2212 by 1672 pixels; CFP: 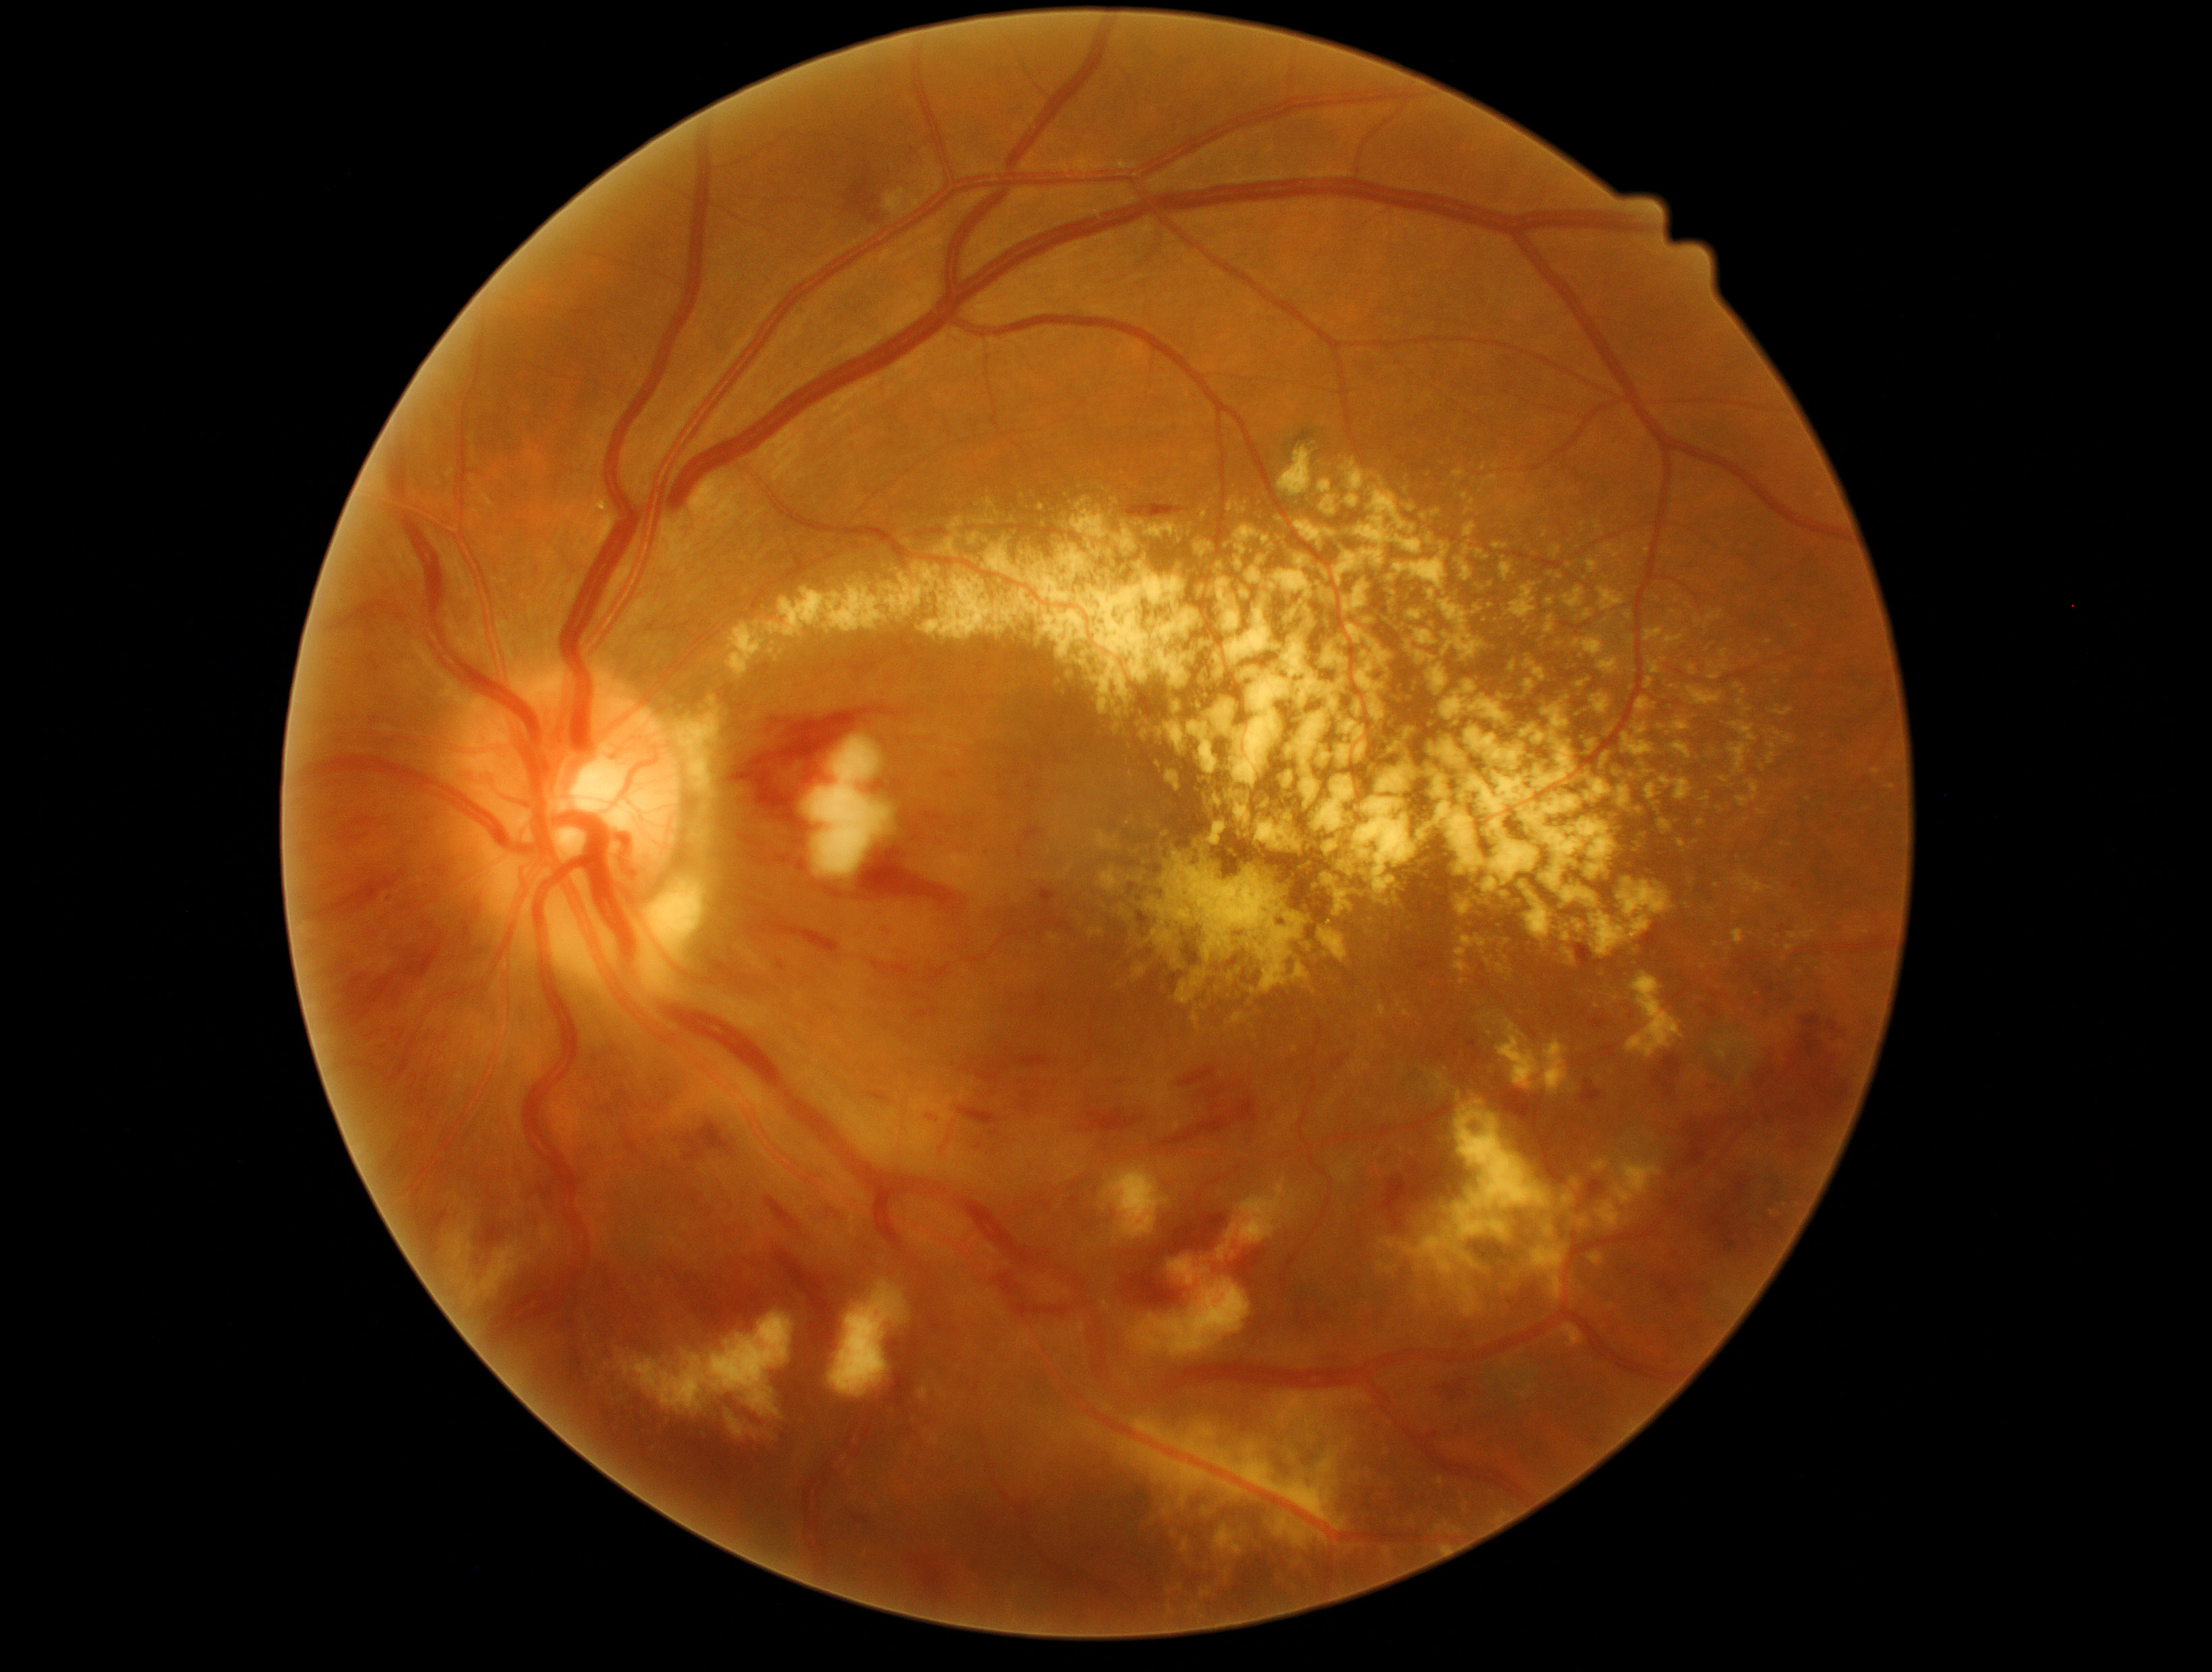 partial: true
dr_grade: 3
lesions:
  ex:
    - [x1=1746, y1=781, x2=1759, y2=804]
    - [x1=1464, y1=525, x2=1478, y2=541]
    - [x1=1672, y1=744, x2=1688, y2=760]
    - [x1=1592, y1=737, x2=1612, y2=769]
    - [x1=1627, y1=973, x2=1685, y2=1059]
    - [x1=1657, y1=595, x2=1680, y2=618]
    - [x1=1563, y1=589, x2=1598, y2=621]
    - [x1=1703, y1=753, x2=1726, y2=761]
    - [x1=1215, y1=1527, x2=1243, y2=1555]
    - [x1=1085, y1=543, x2=1139, y2=587]
    - [x1=1452, y1=938, x2=1482, y2=990]
    - [x1=1352, y1=491, x2=1451, y2=624]
    - [x1=1700, y1=791, x2=1708, y2=803]
    - [x1=1196, y1=533, x2=1216, y2=555]
    - [x1=1510, y1=659, x2=1517, y2=678]
    - [x1=1768, y1=742, x2=1777, y2=750]
  ex_small:
    - [x=1794, y=627]
    - [x=1627, y=1222]
    - [x=1489, y=1032]